Acquired with a Remidio smartphone fundus camera, 1659x2212, color fundus photograph:
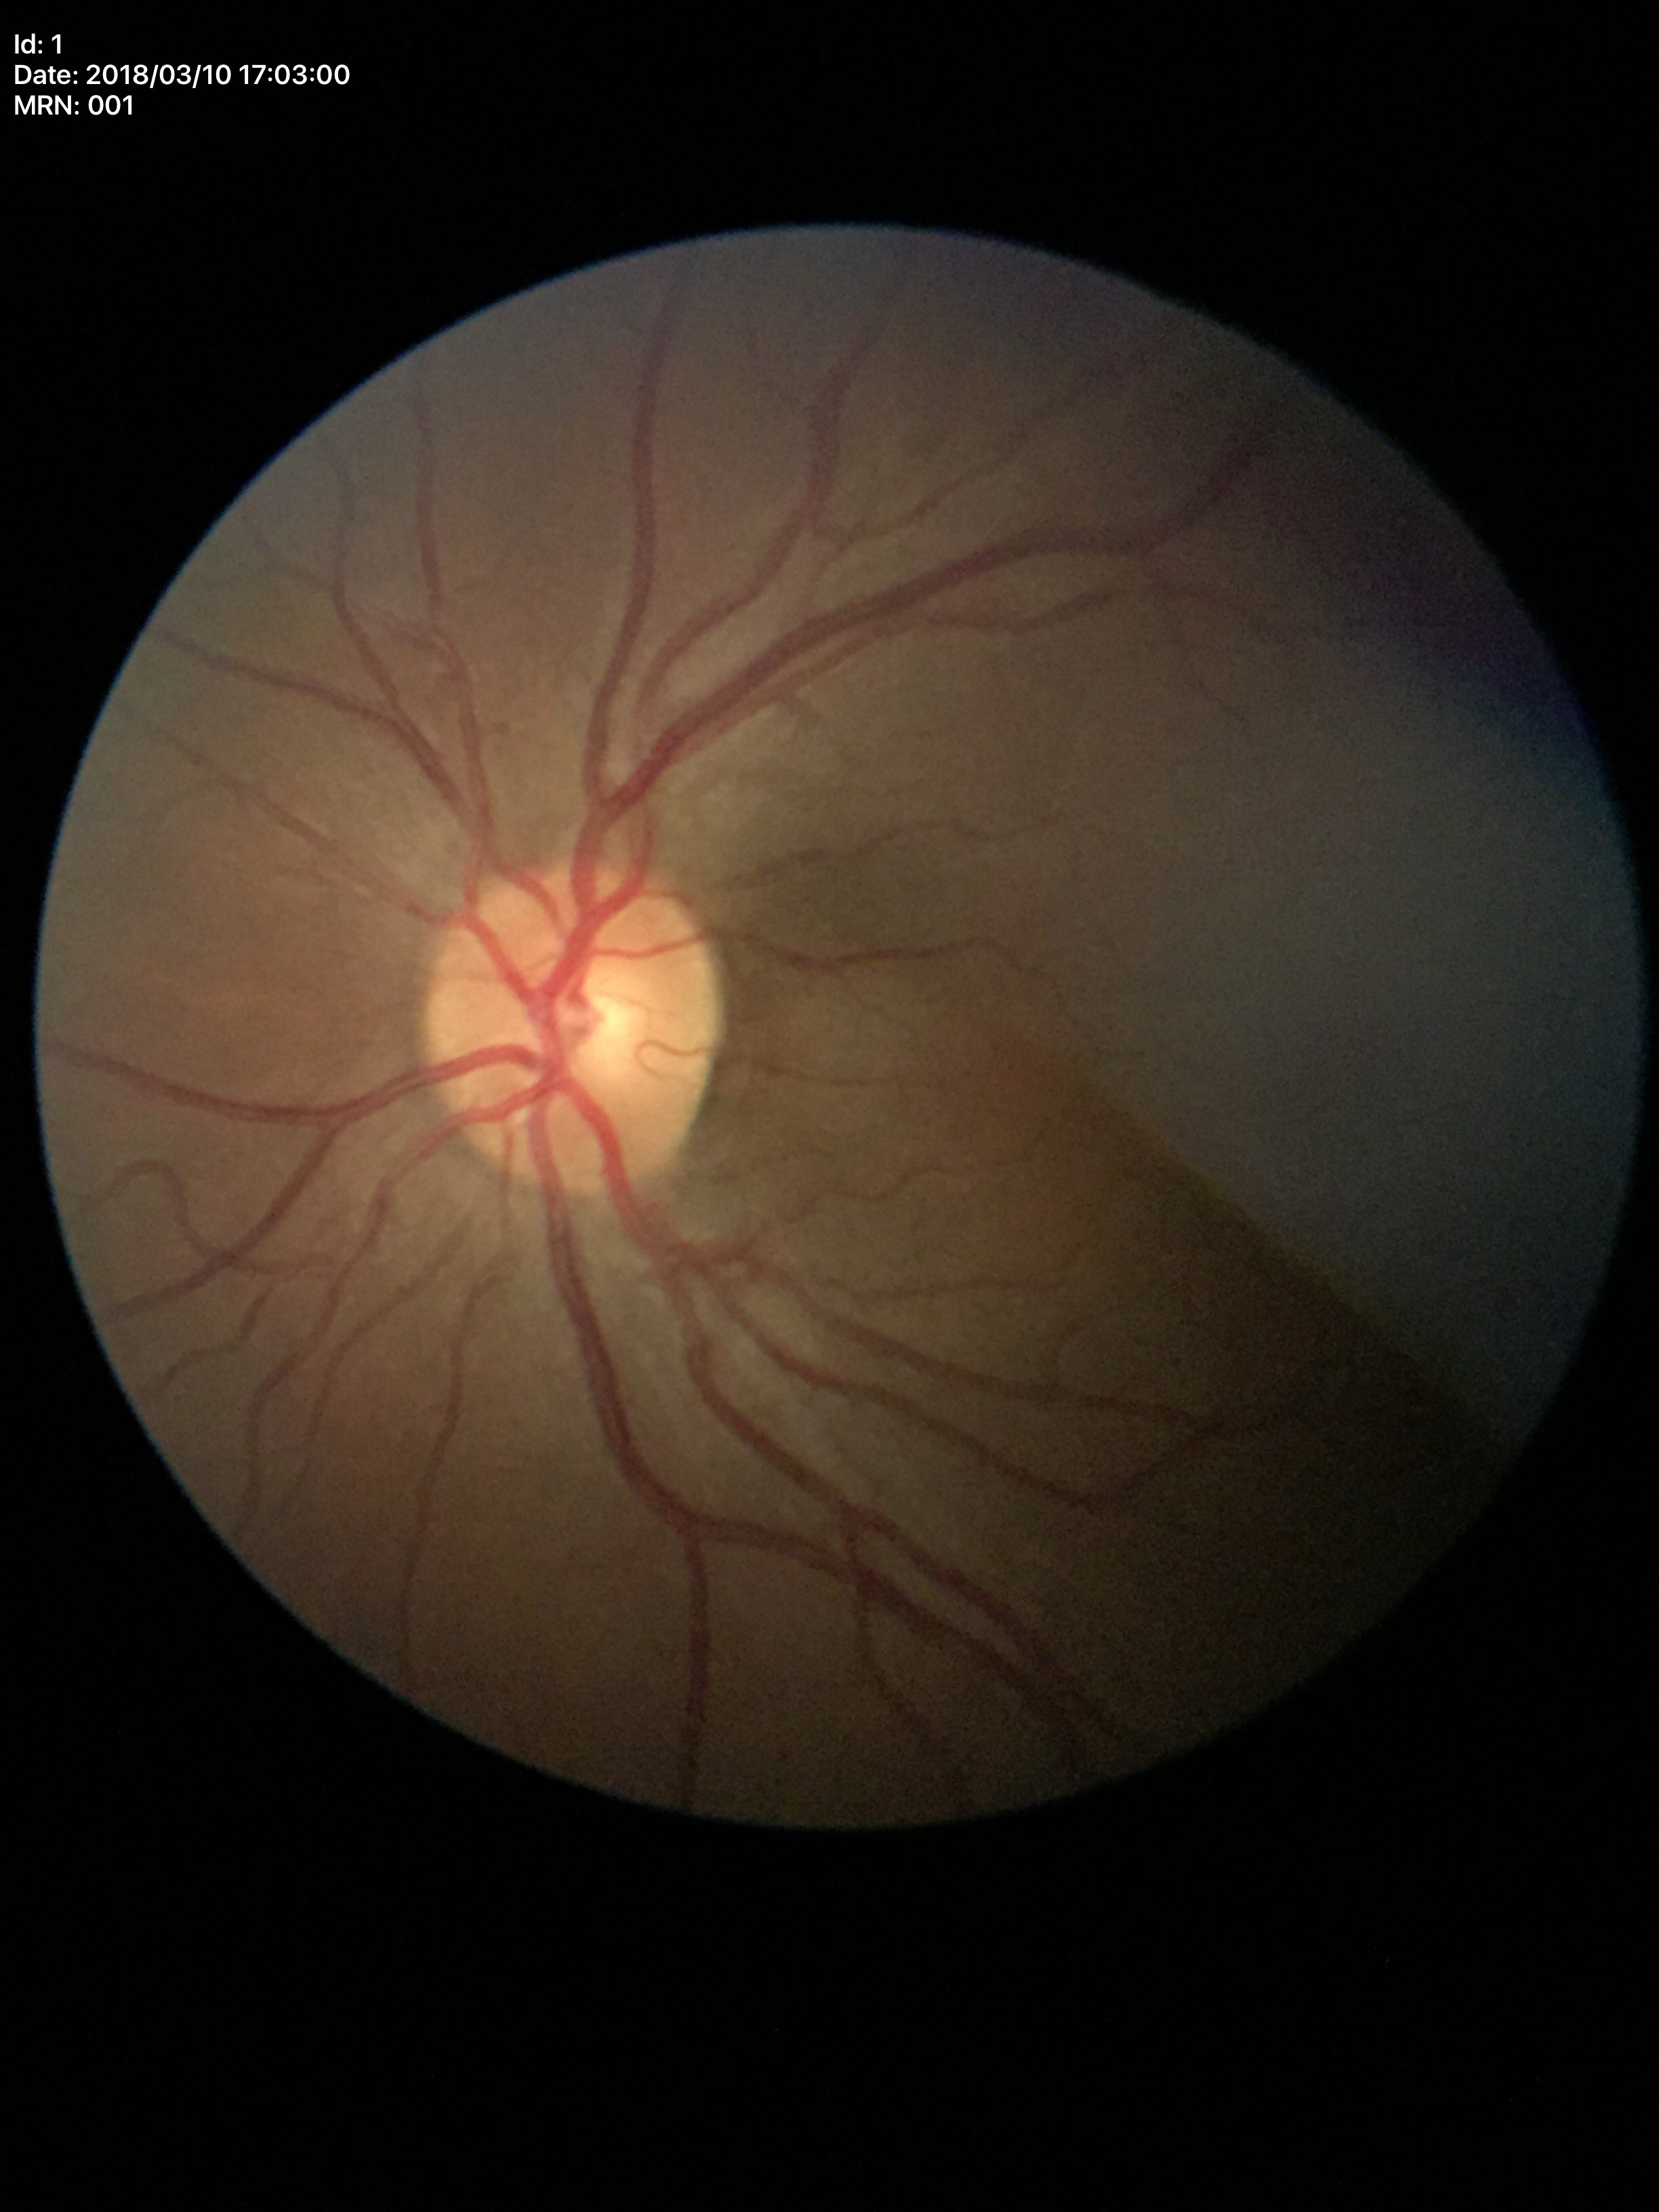

Glaucoma screening impression: not suspect.
Vertical cup-to-disc ratio: 0.43.
Area CDR: 0.20.
Horizontal cup-disc ratio of 0.47.